Color fundus photograph:
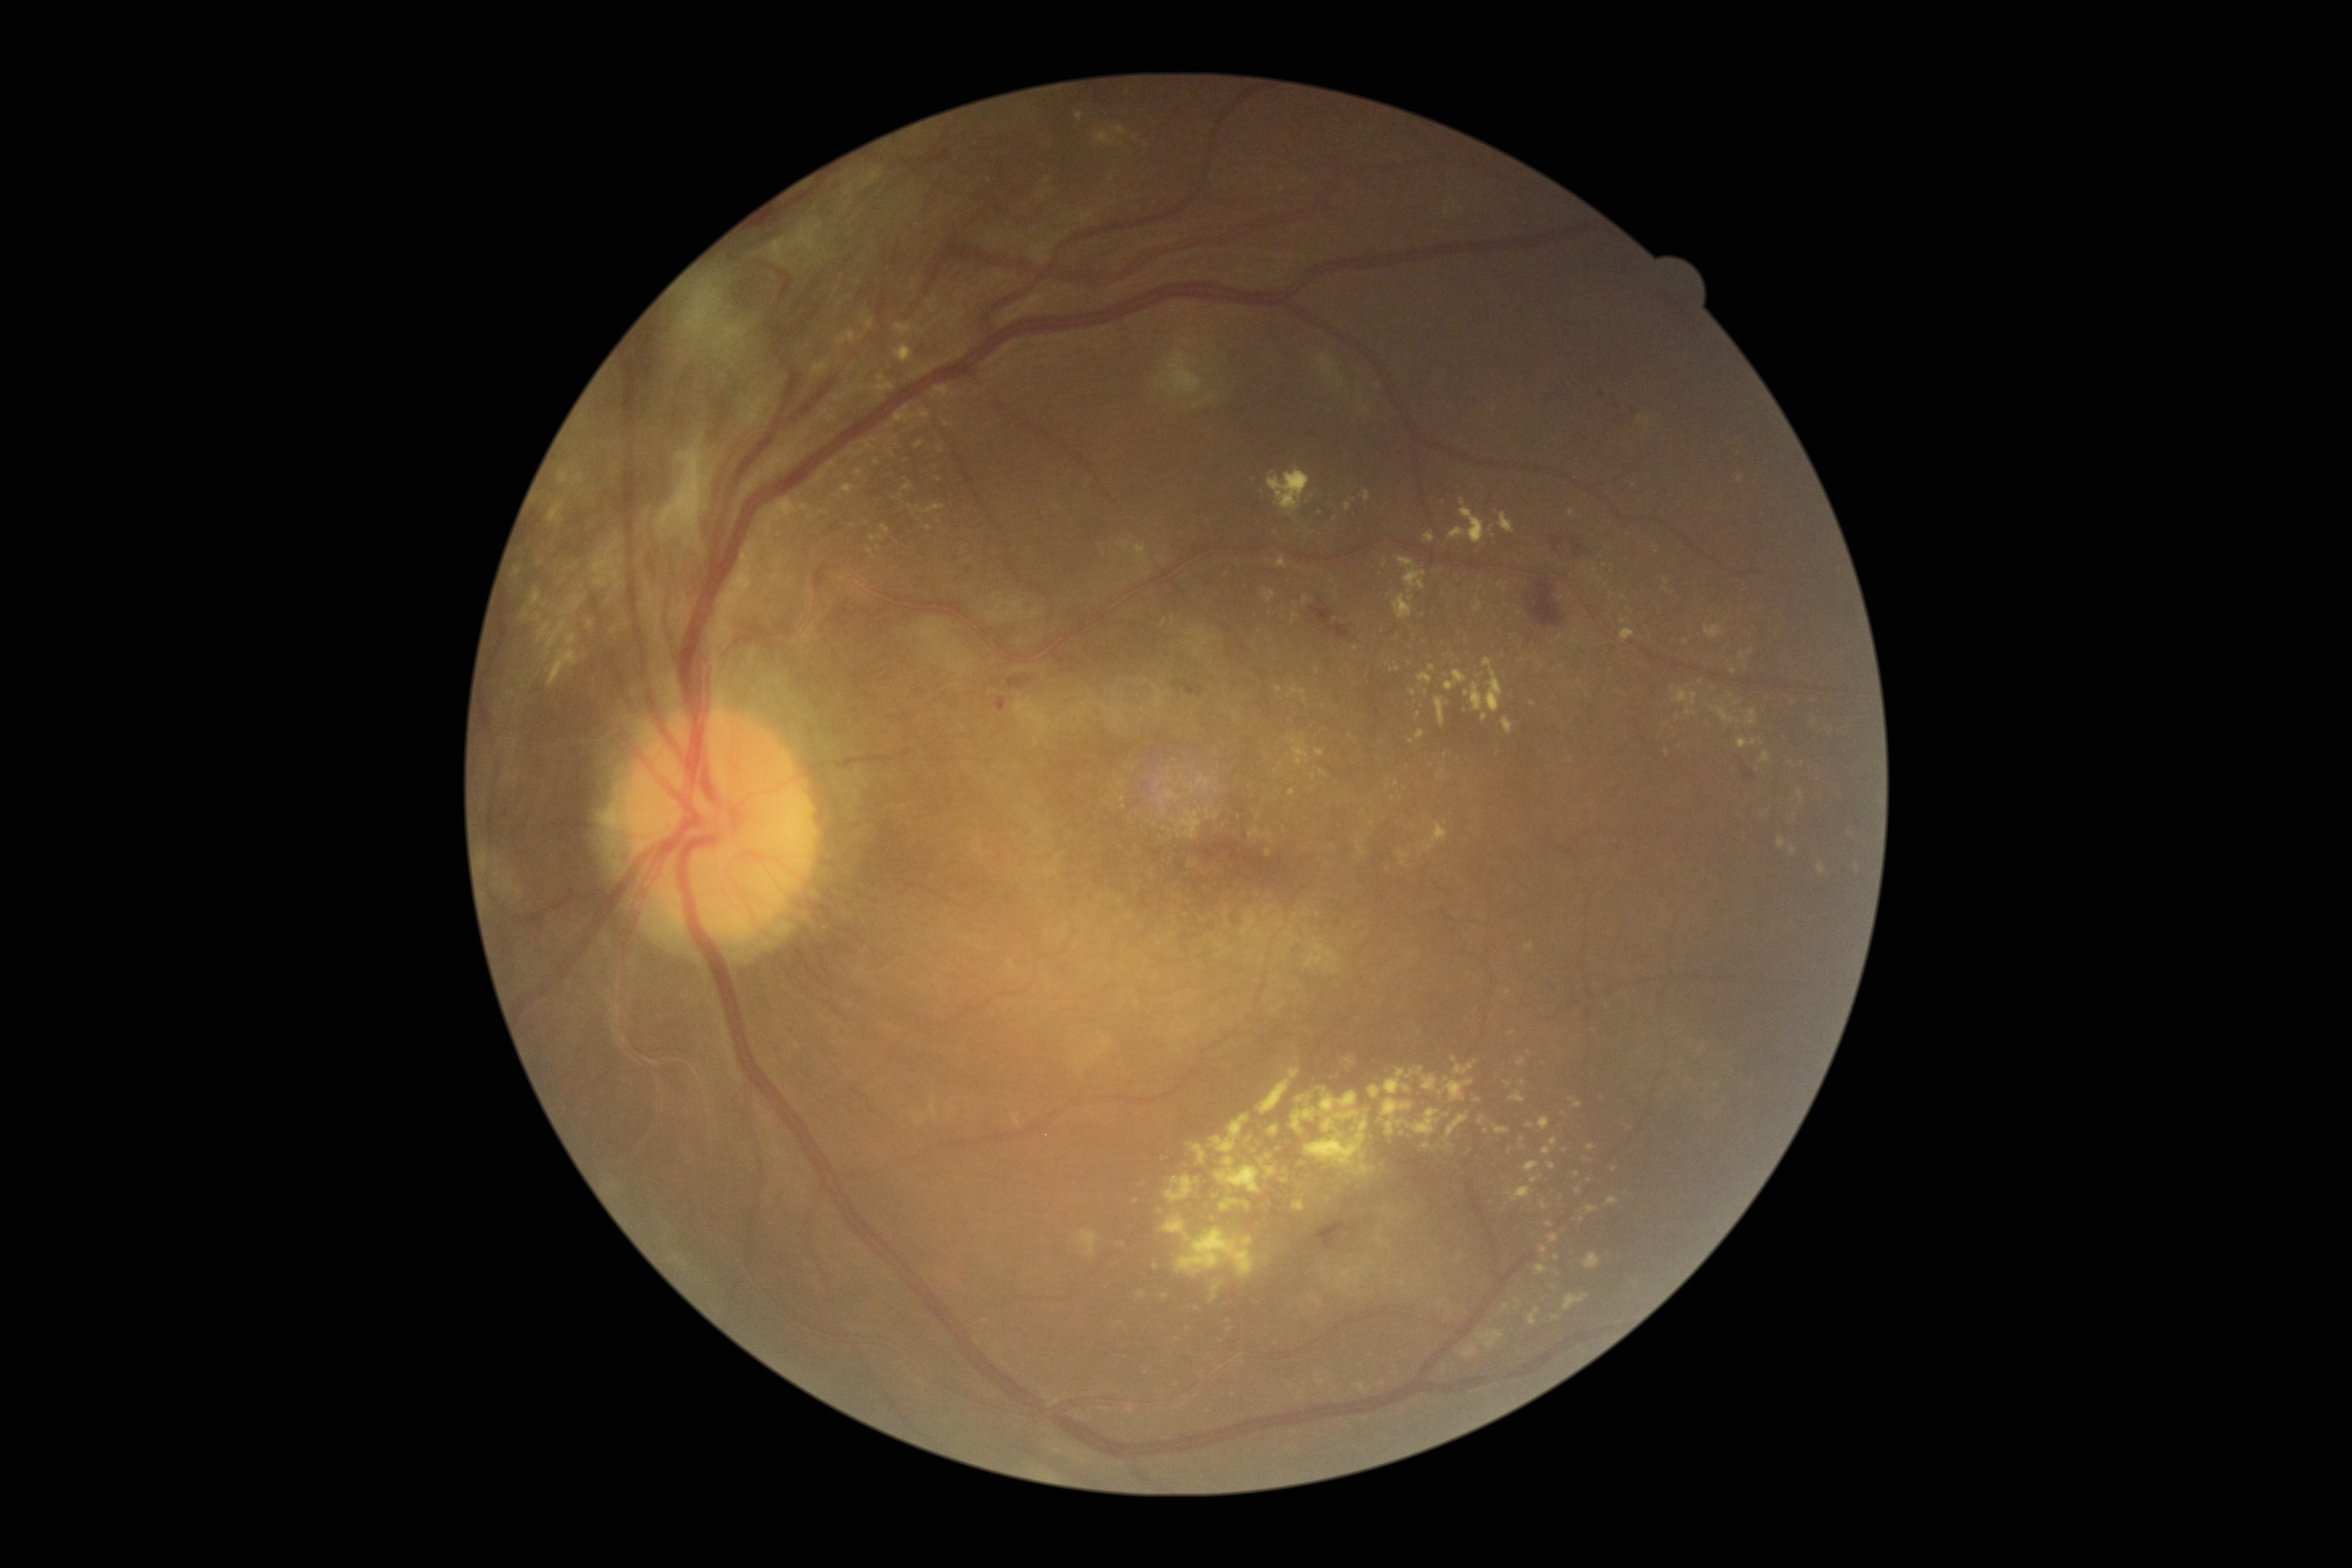 DR severity is proliferative diabetic retinopathy (grade 4)
Lesions identified (partial list):
• EXs (subset): bbox(1419, 673, 1432, 684), bbox(1382, 557, 1387, 569), bbox(1267, 1126, 1279, 1135), bbox(1437, 769, 1445, 779), bbox(1368, 1085, 1381, 1099), bbox(903, 483, 913, 491), bbox(895, 405, 931, 424), bbox(1737, 737, 1763, 748), bbox(1564, 1293, 1589, 1310), bbox(537, 619, 572, 659)
• Smaller EXs around [x=1557, y=1257], [x=837, y=495], [x=1589, y=1180], [x=1380, y=1242], [x=1480, y=675], [x=1448, y=703], [x=1529, y=1052], [x=1155, y=1266], [x=928, y=529]